2346 by 1568 pixels — 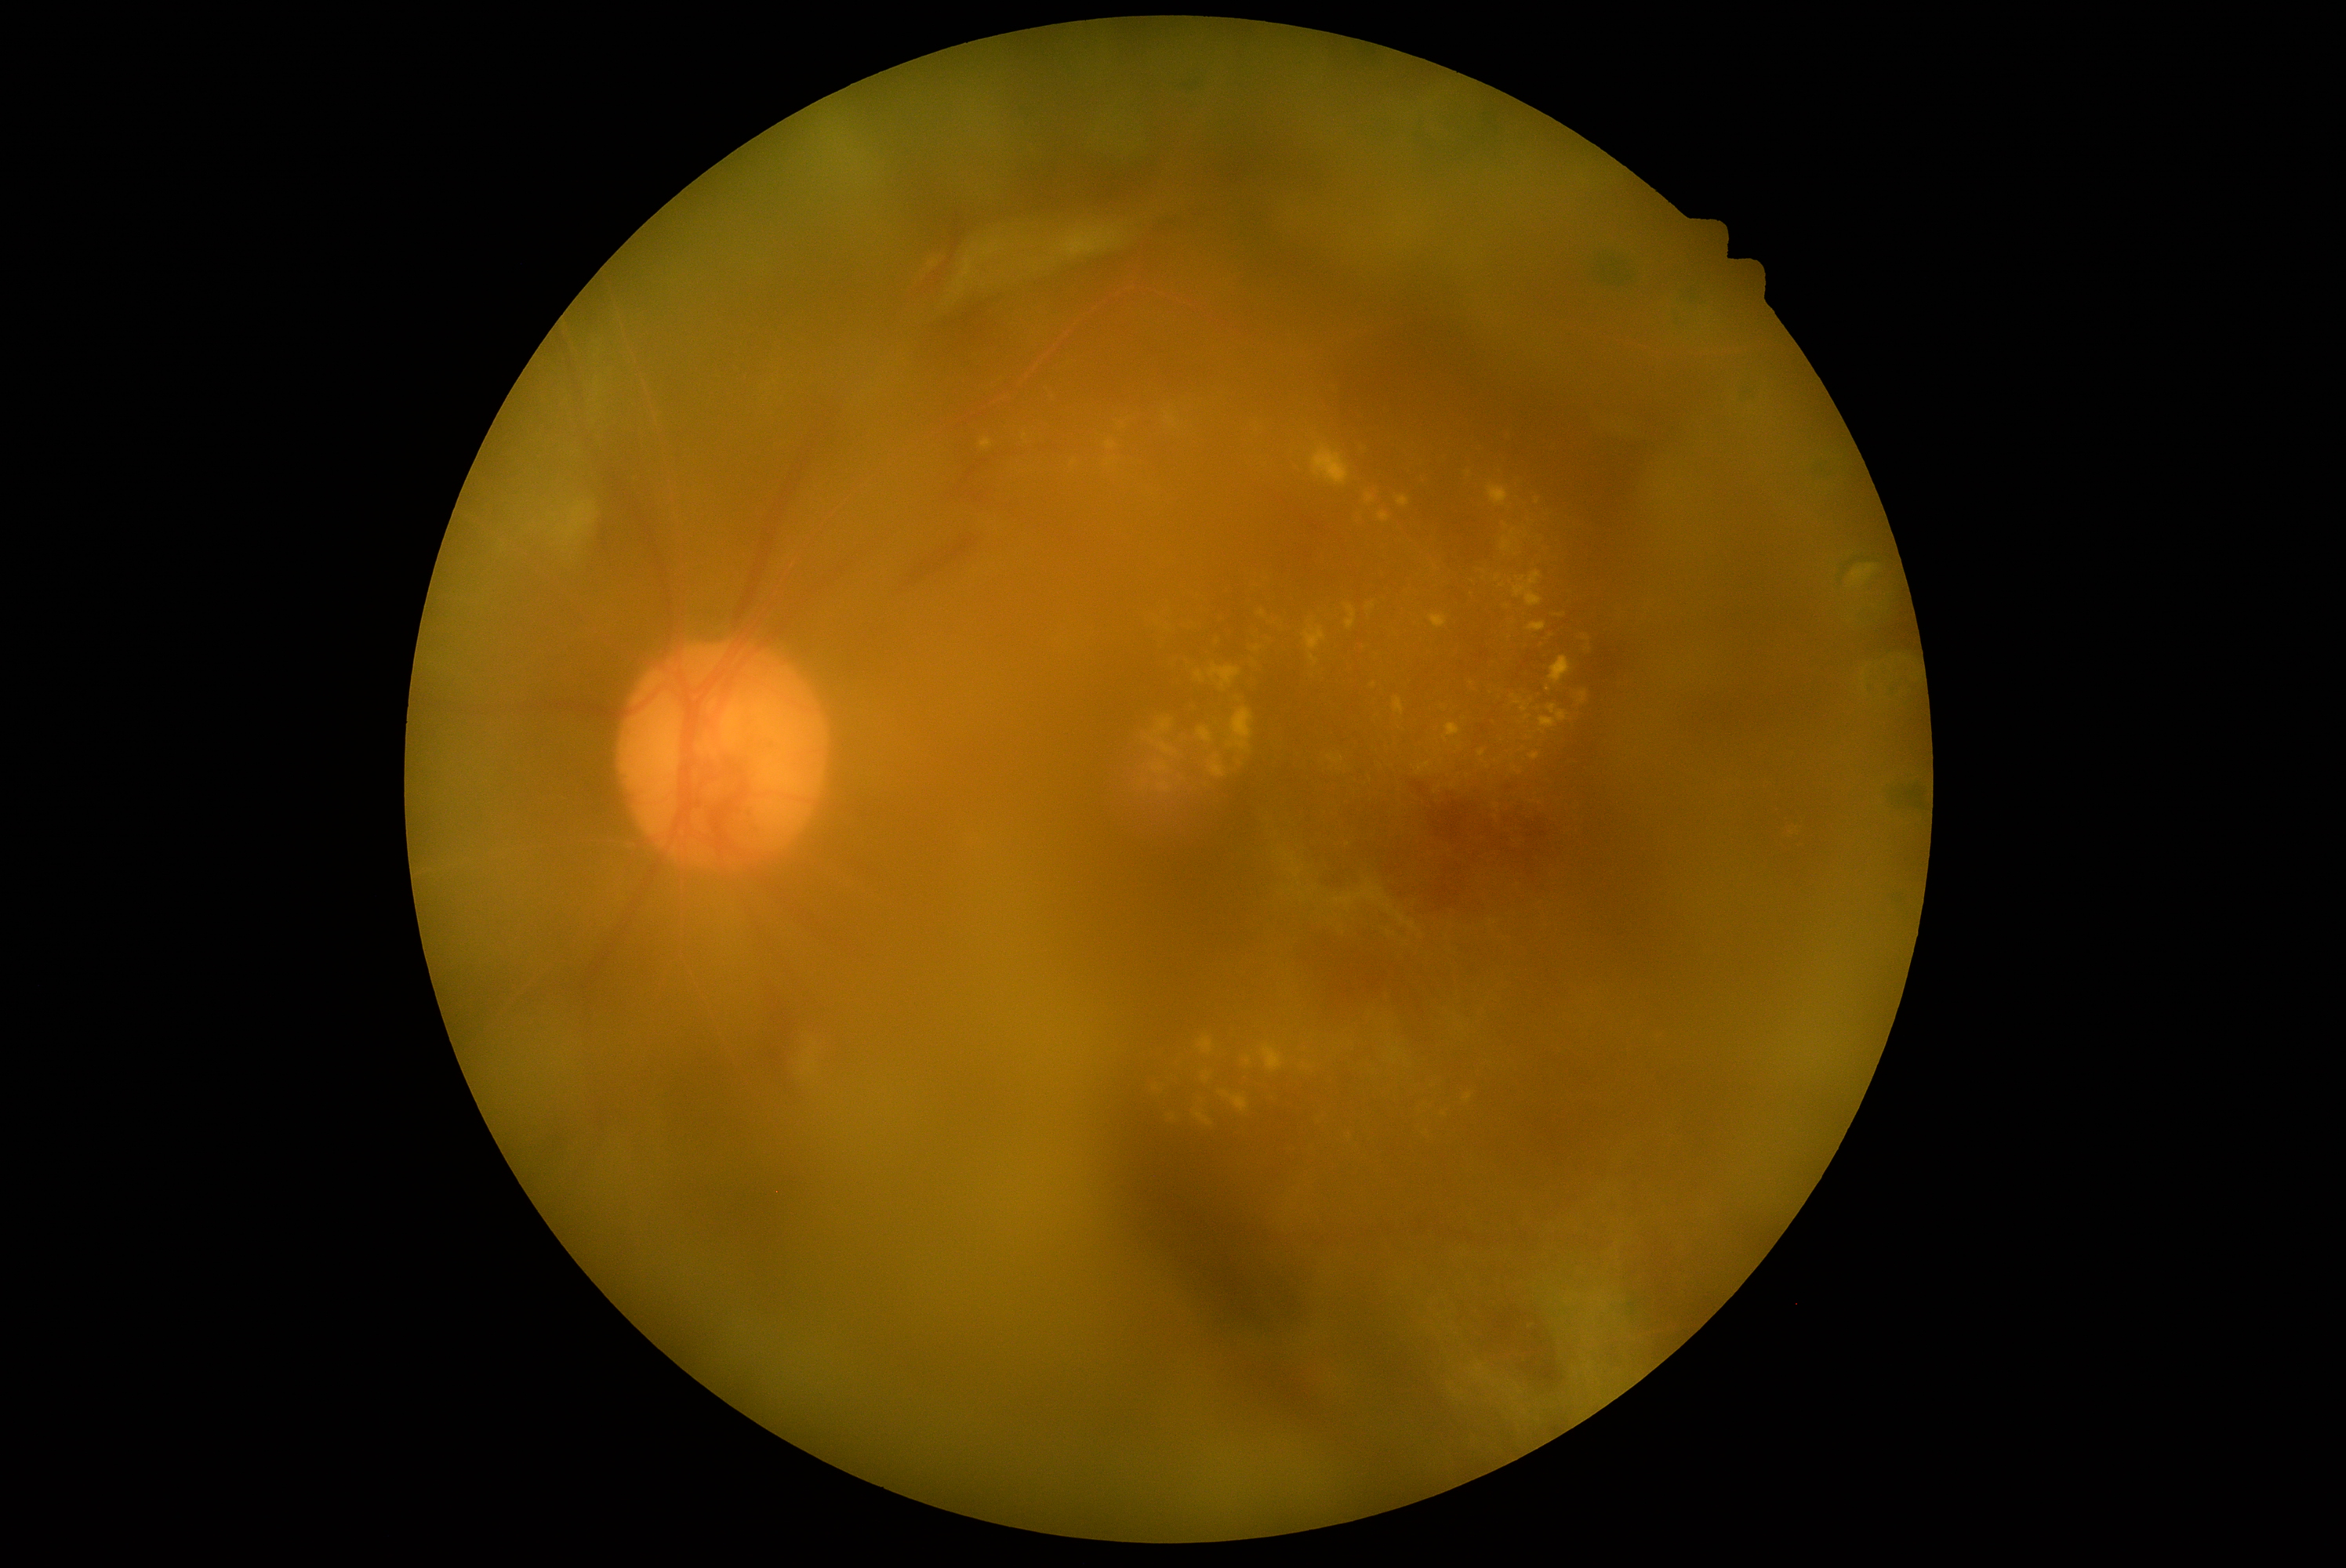
Retinopathy: grade 4.